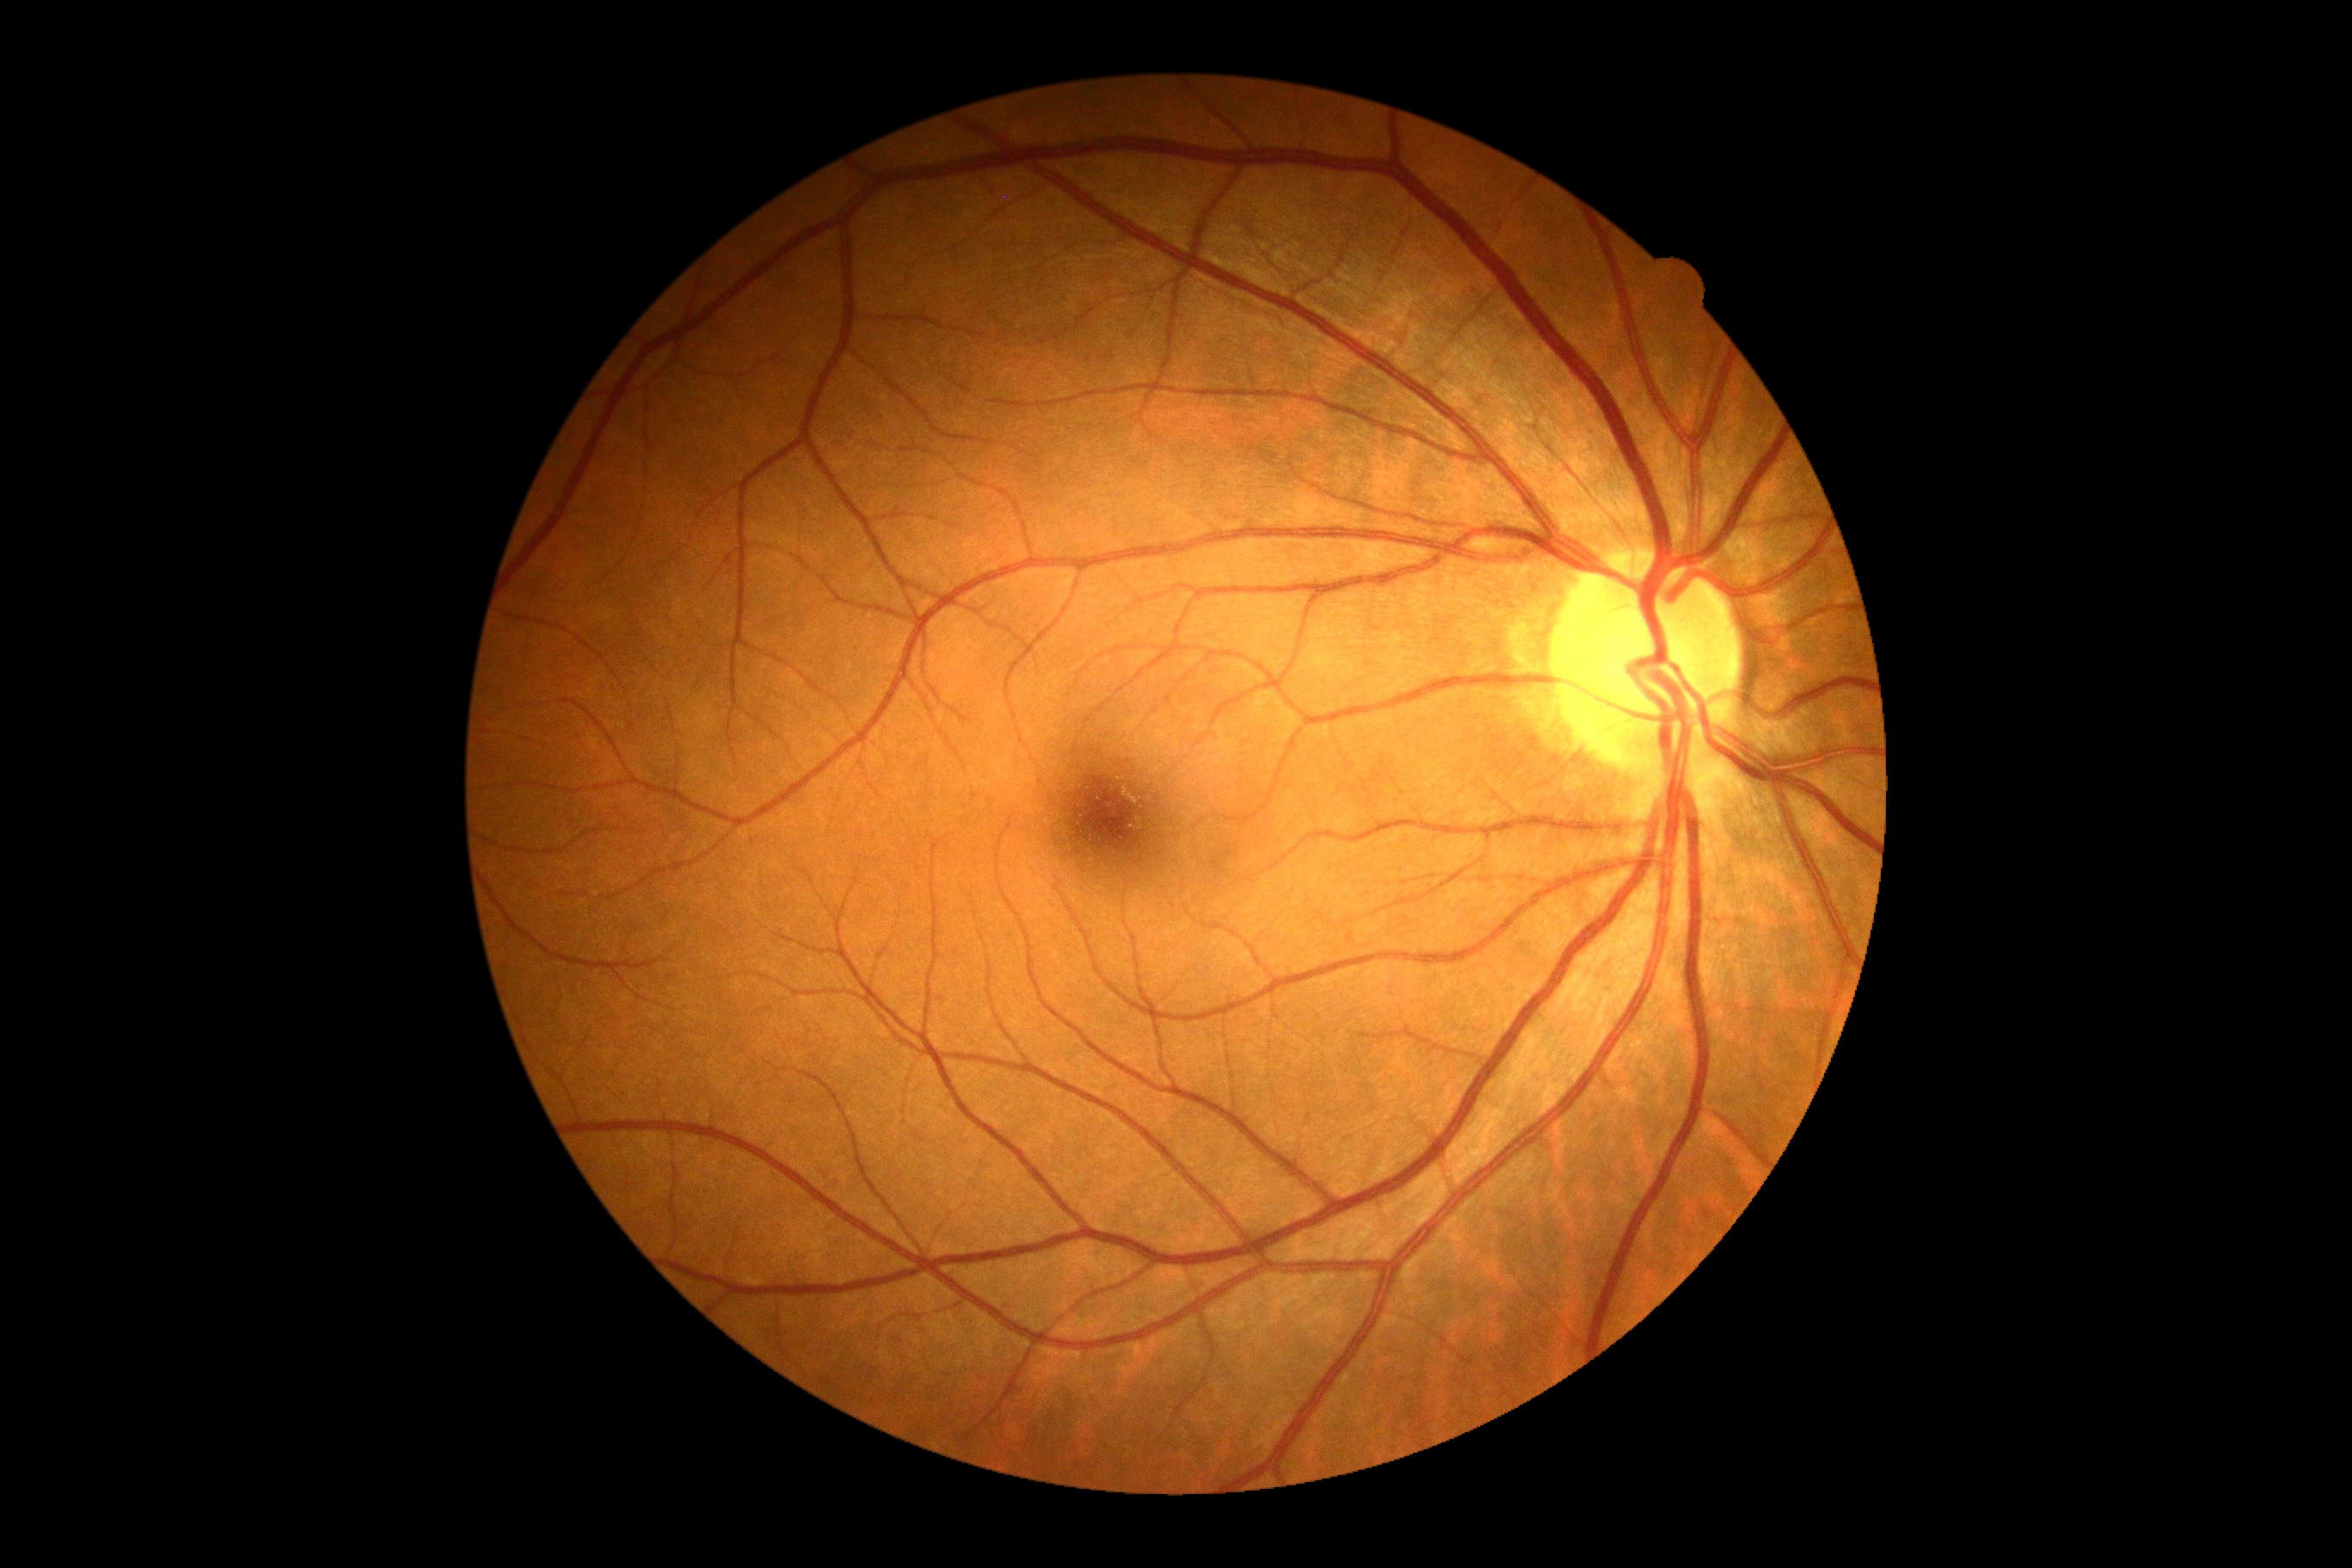

Findings:
* diabetic retinopathy: grade 0 (no apparent retinopathy)